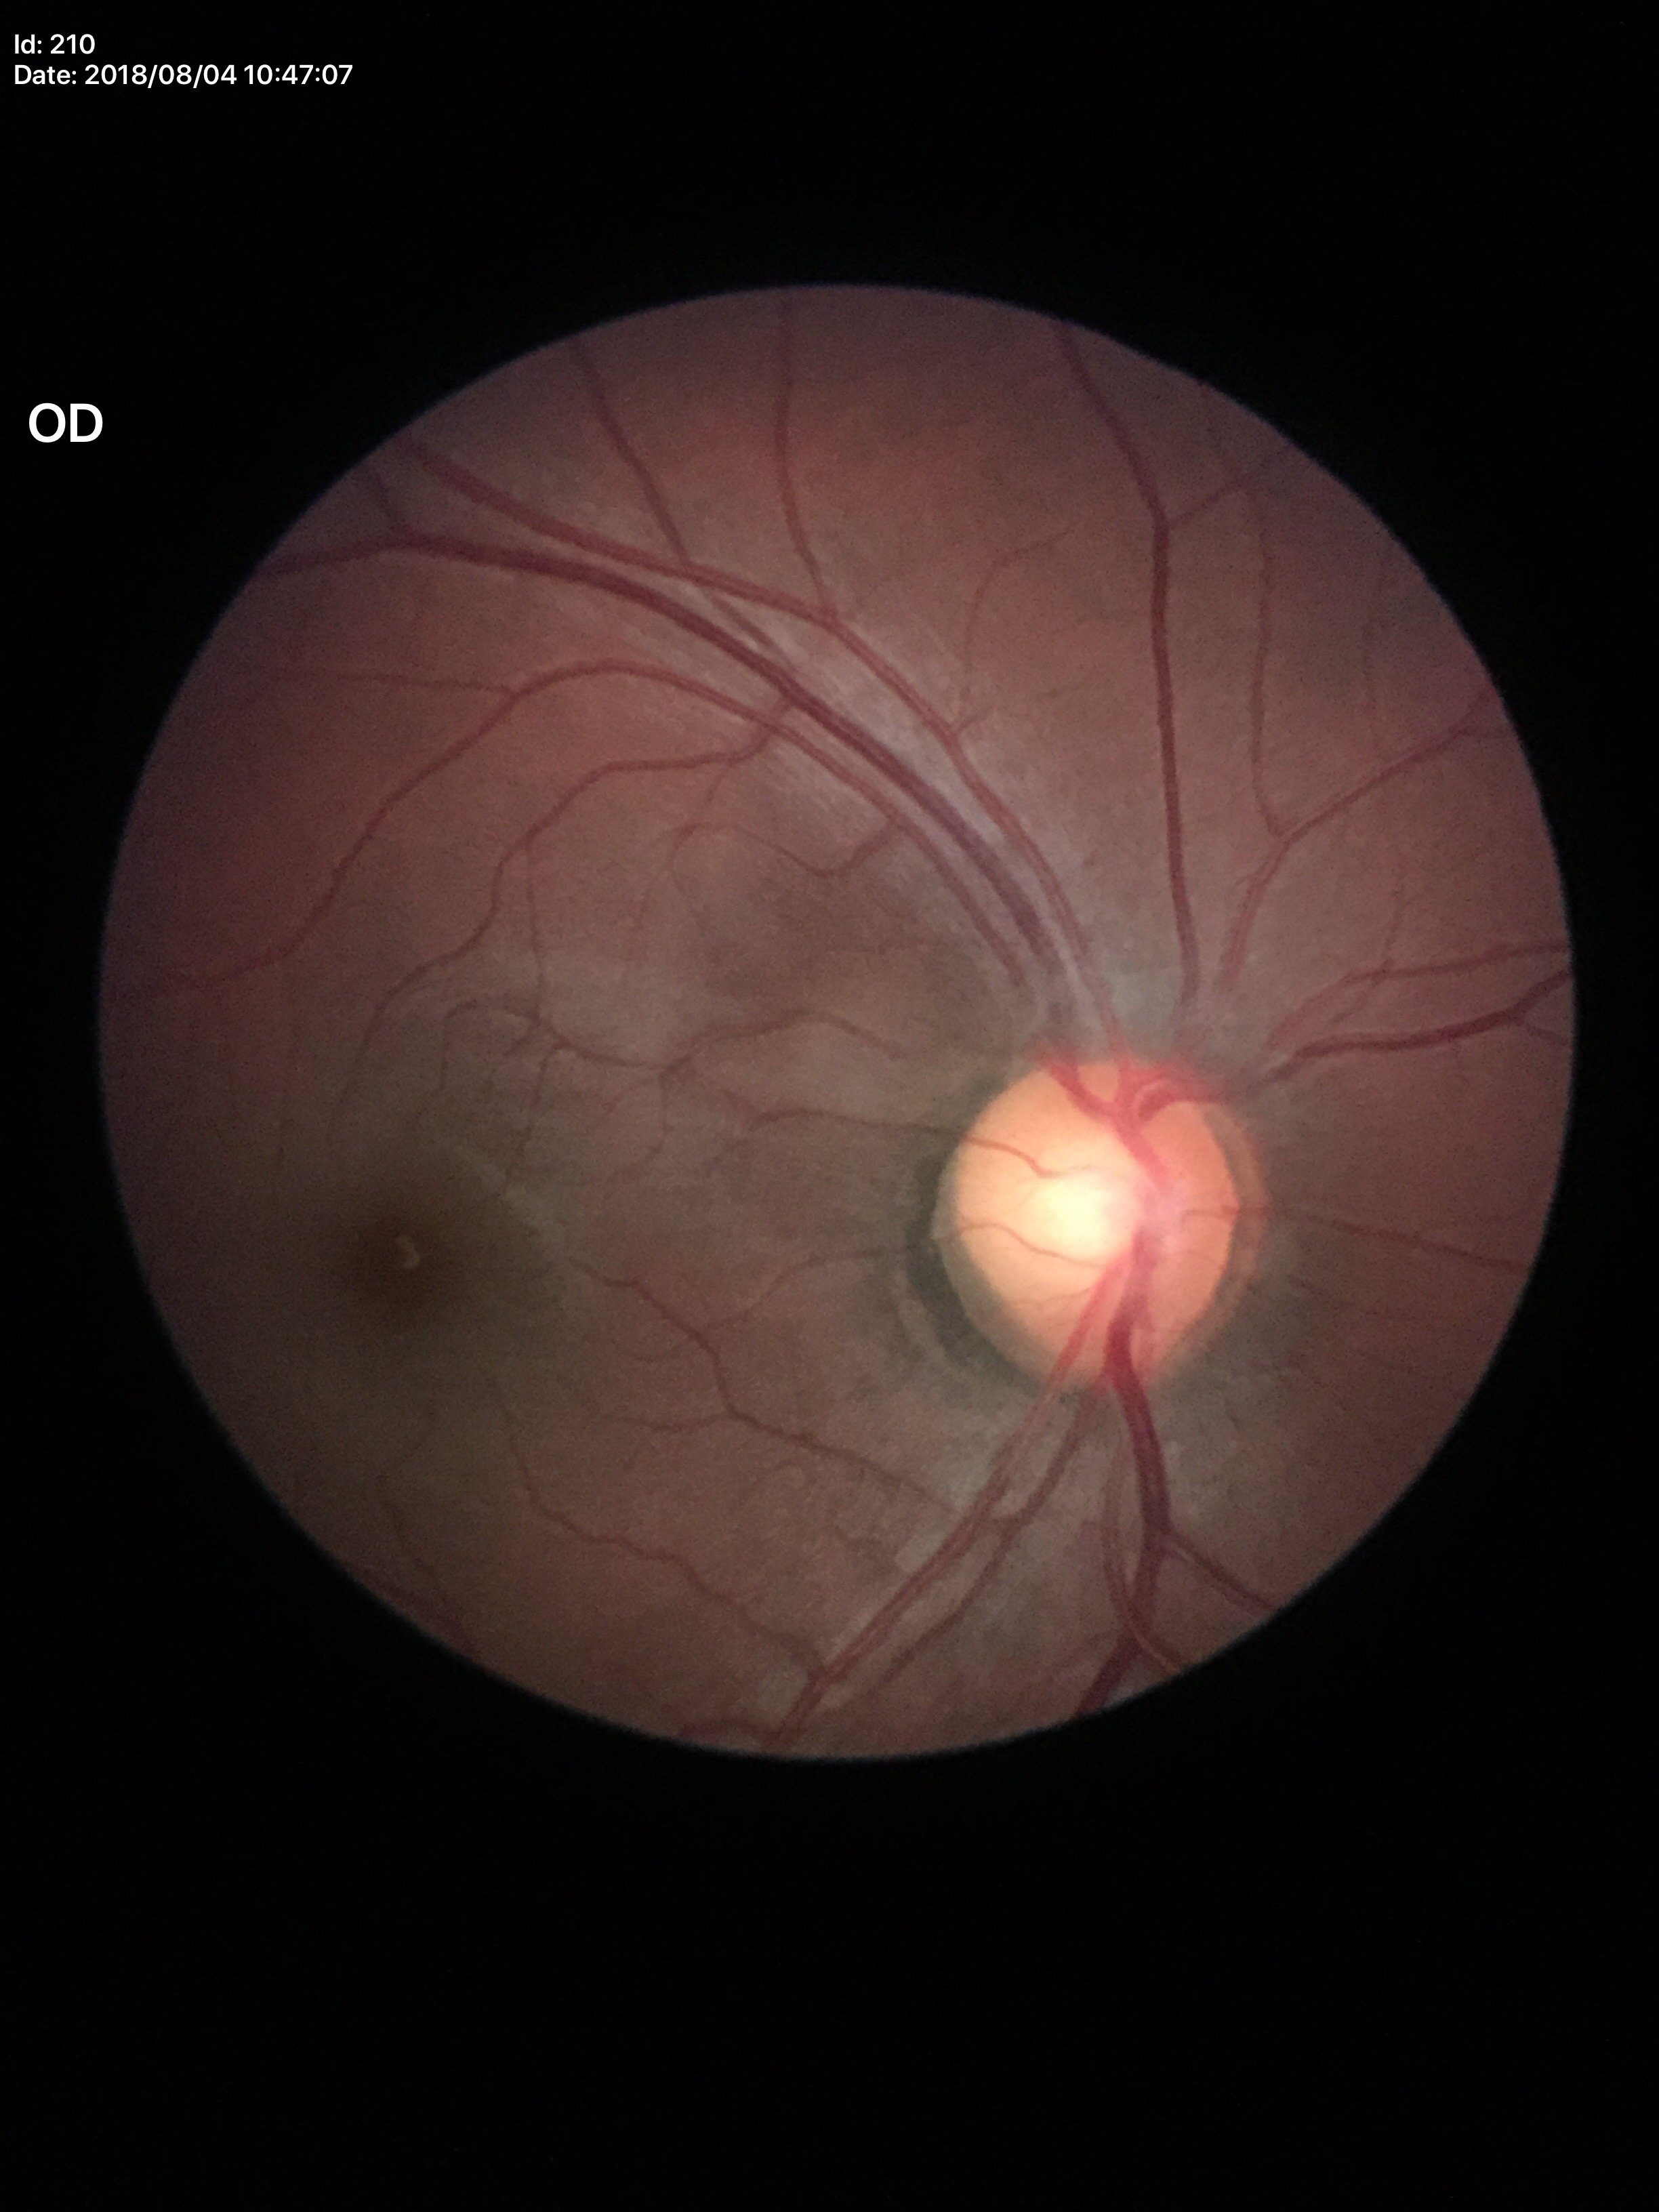

horizontal cup-disc ratio=0.58
vertical C/D ratio=0.53
Glaucoma decision=no suspicious findings